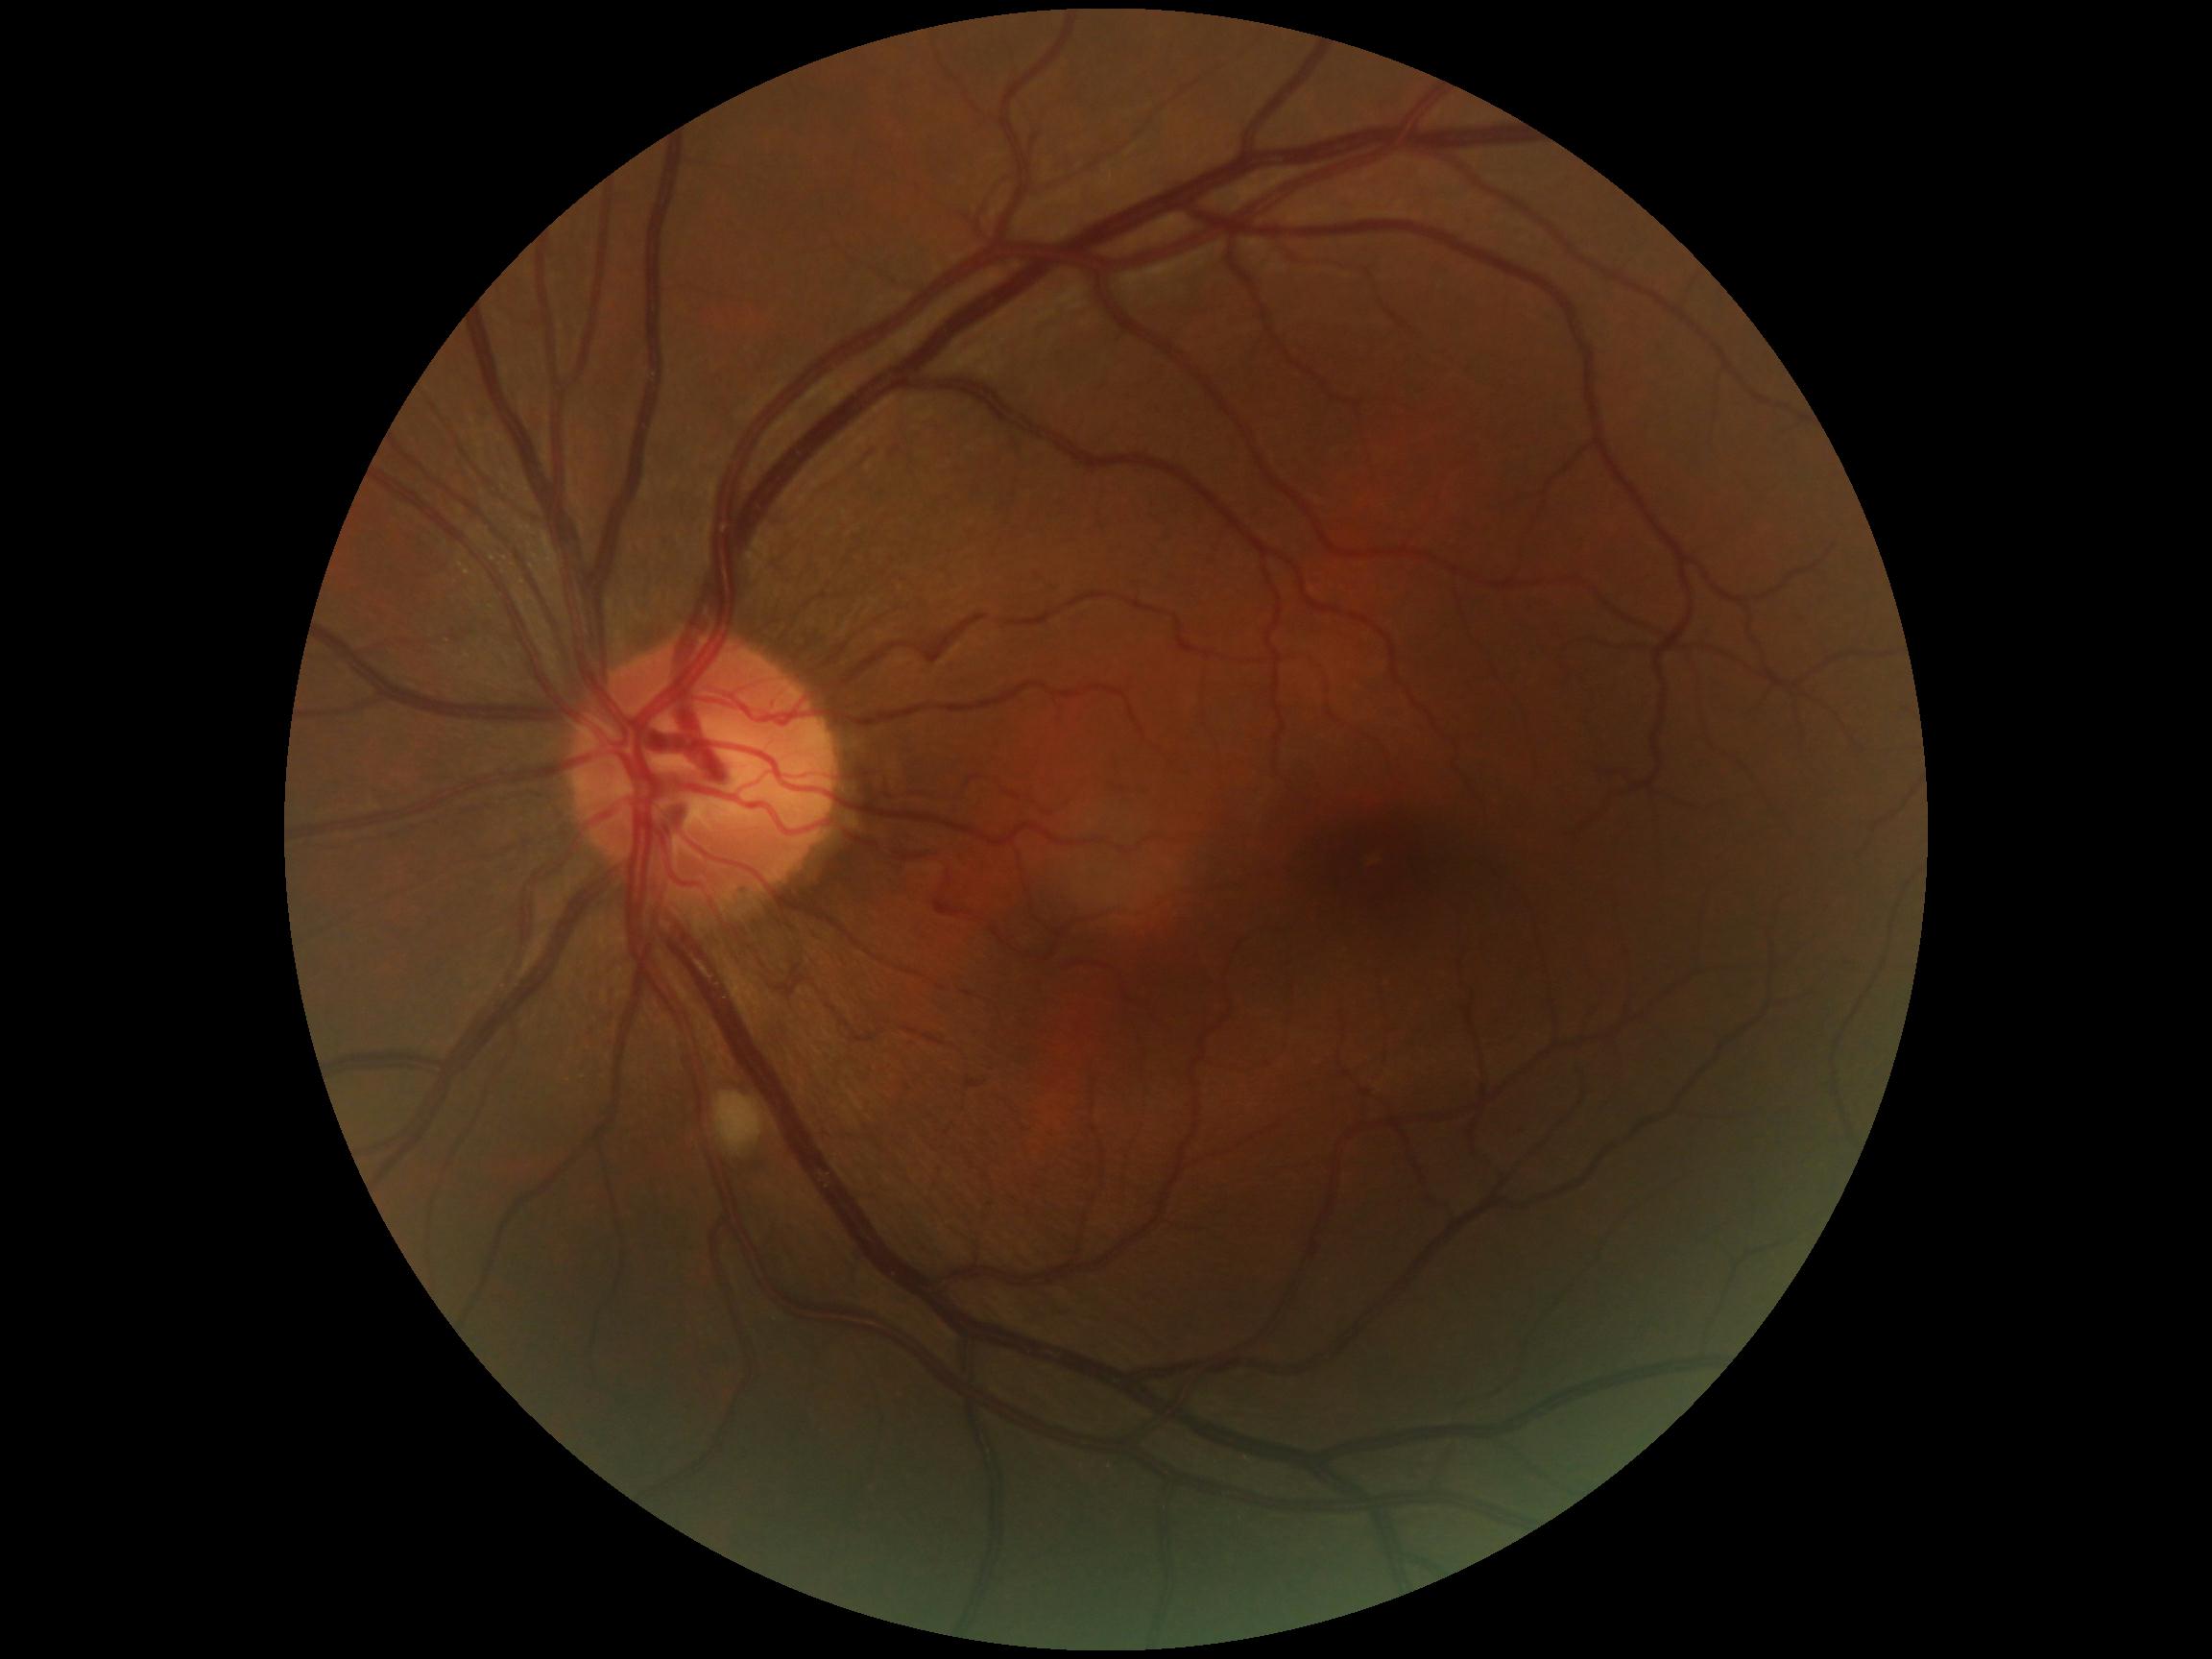

retinopathy: 2 — more than just microaneurysms but less than severe NPDR.